Fundus photo. Sex: female. Axial length 22.63 mm.
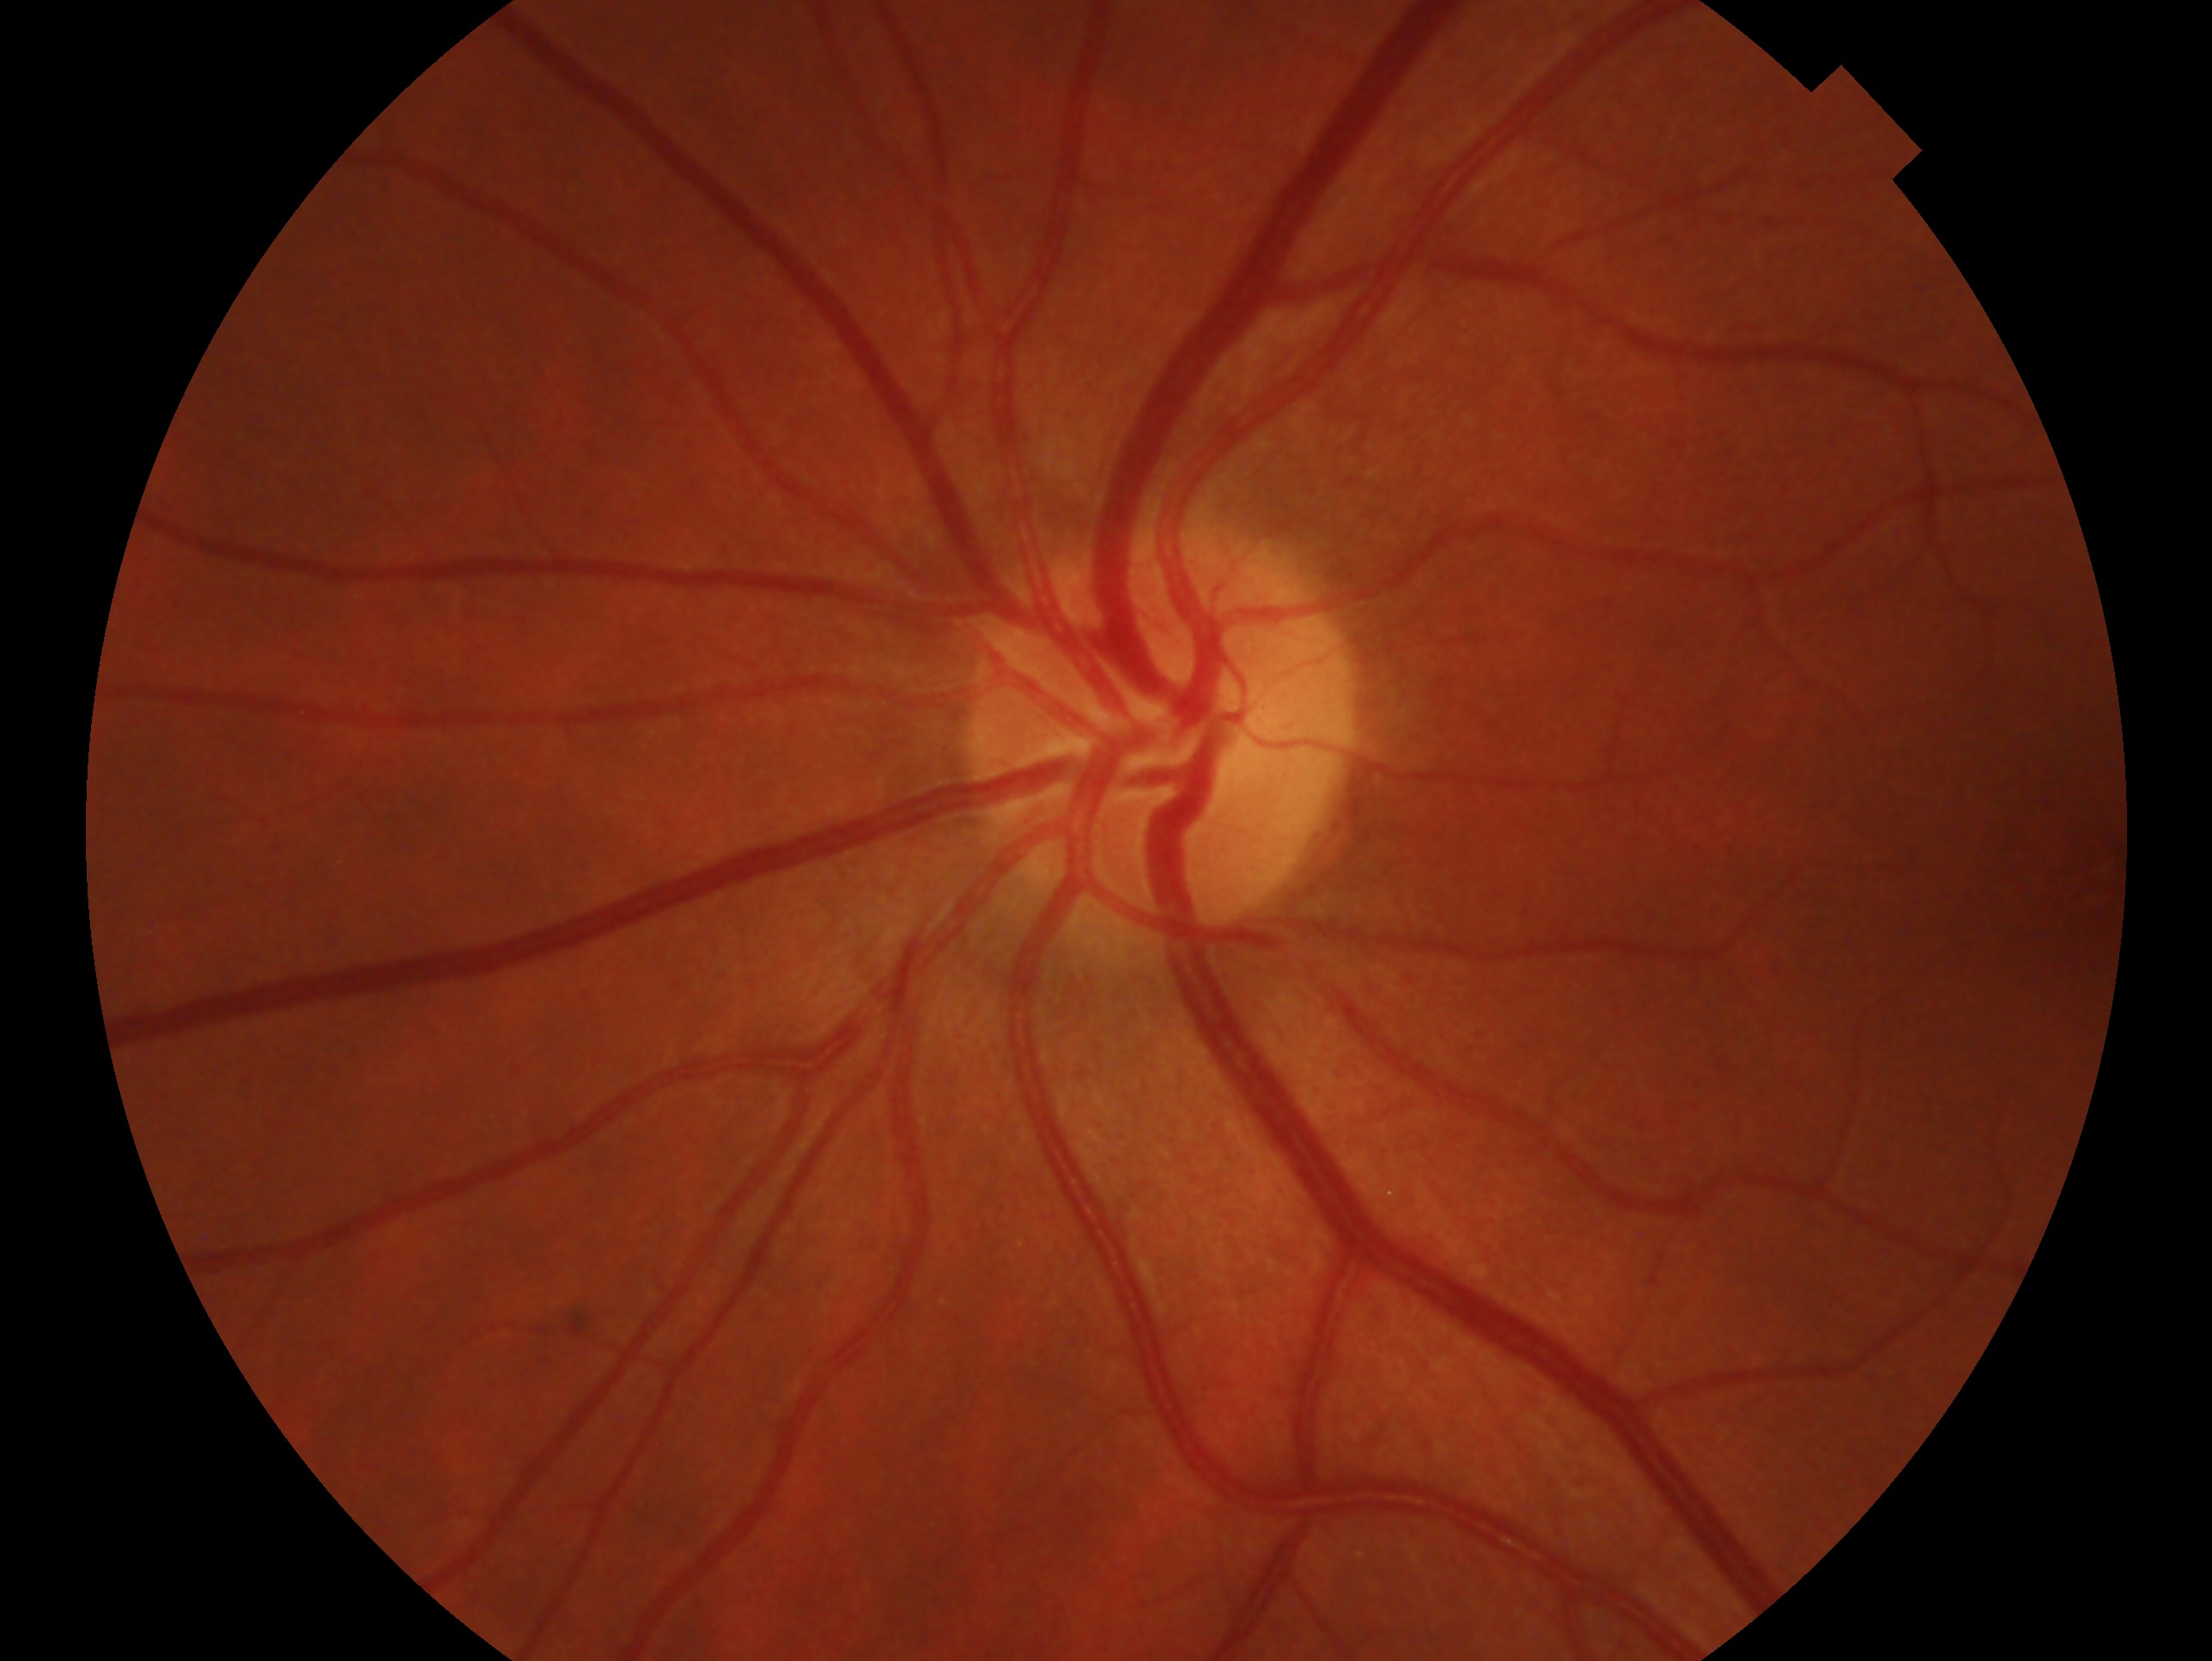

Imaged eye: left. Diagnosis: no glaucomatous findings — no clinical evidence of glaucoma in this eye.